Disc-centered fundus crop
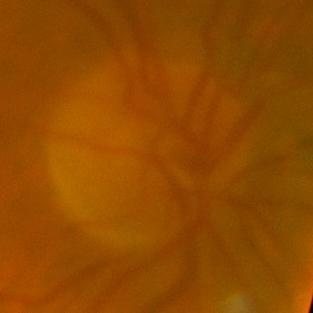 The image shows no evidence of glaucoma.